Non-mydriatic fundus camera. Nidek AFC-330: 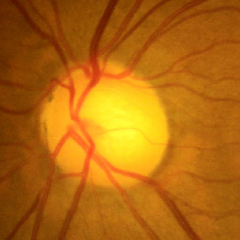

Showing no evidence of glaucoma.